Wide-field fundus photograph of an infant:
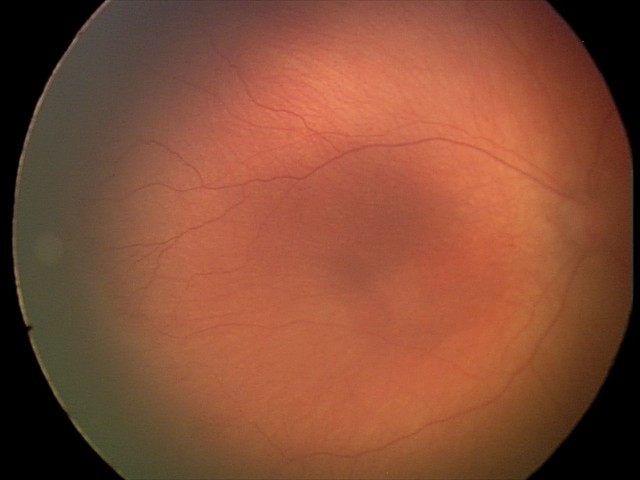
Without plus disease. Series diagnosed as retinopathy of prematurity (ROP) stage 1.